Color fundus image; diabetic retinopathy graded by the modified Davis classification; NIDEK AFC-230.
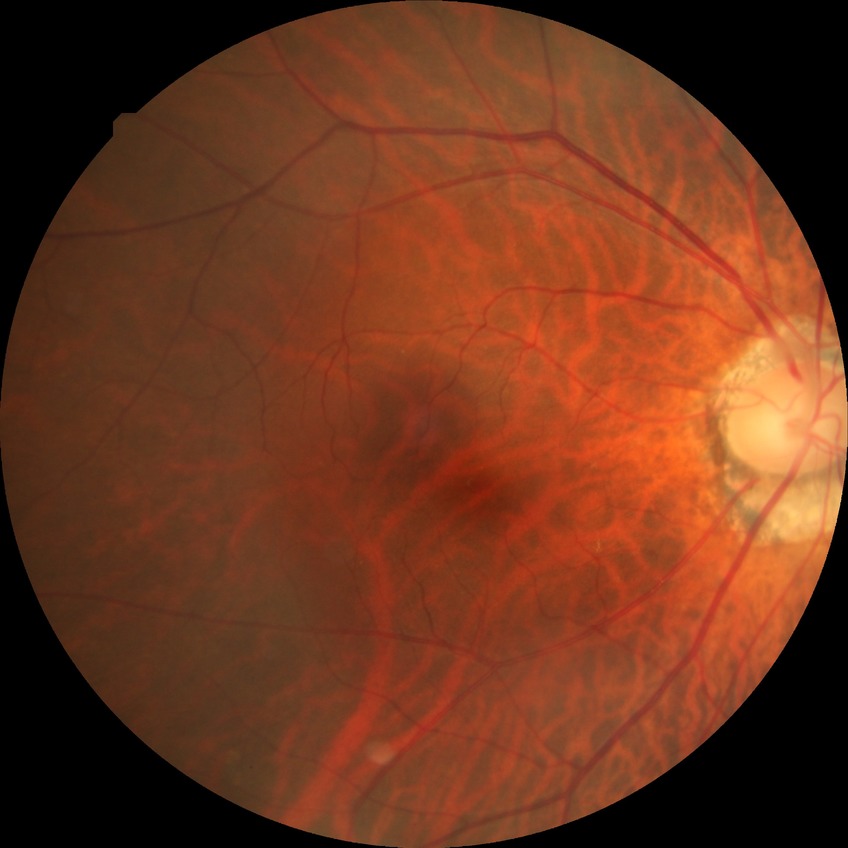 Davis grade: NDR.